848x848
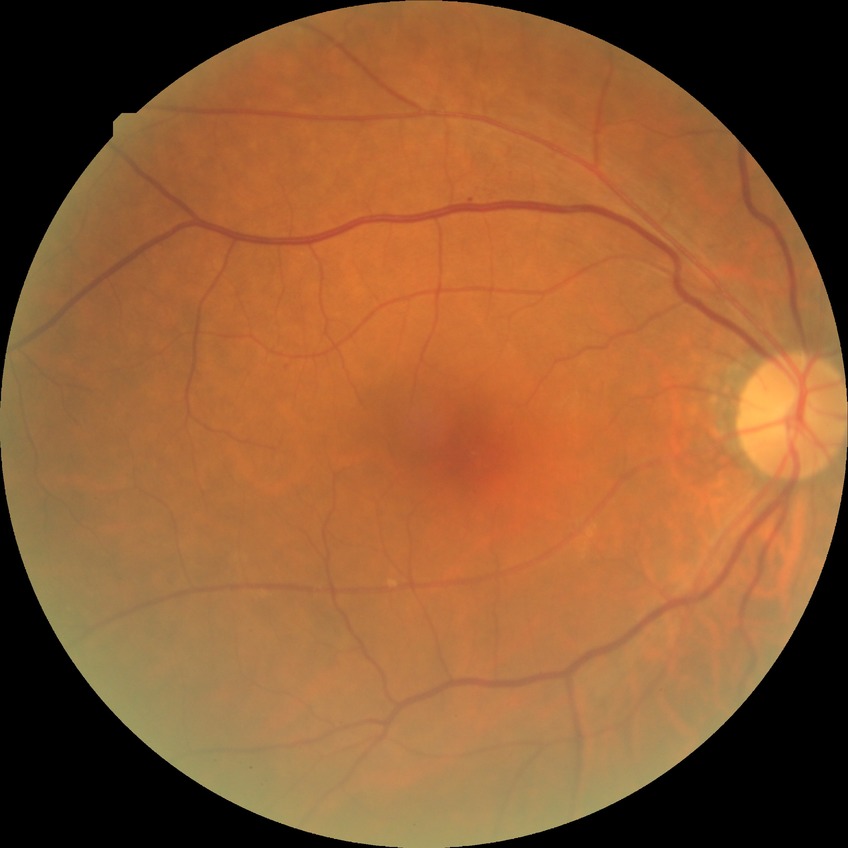 Findings:
– DR grade: SDR